FOV: 45 degrees:
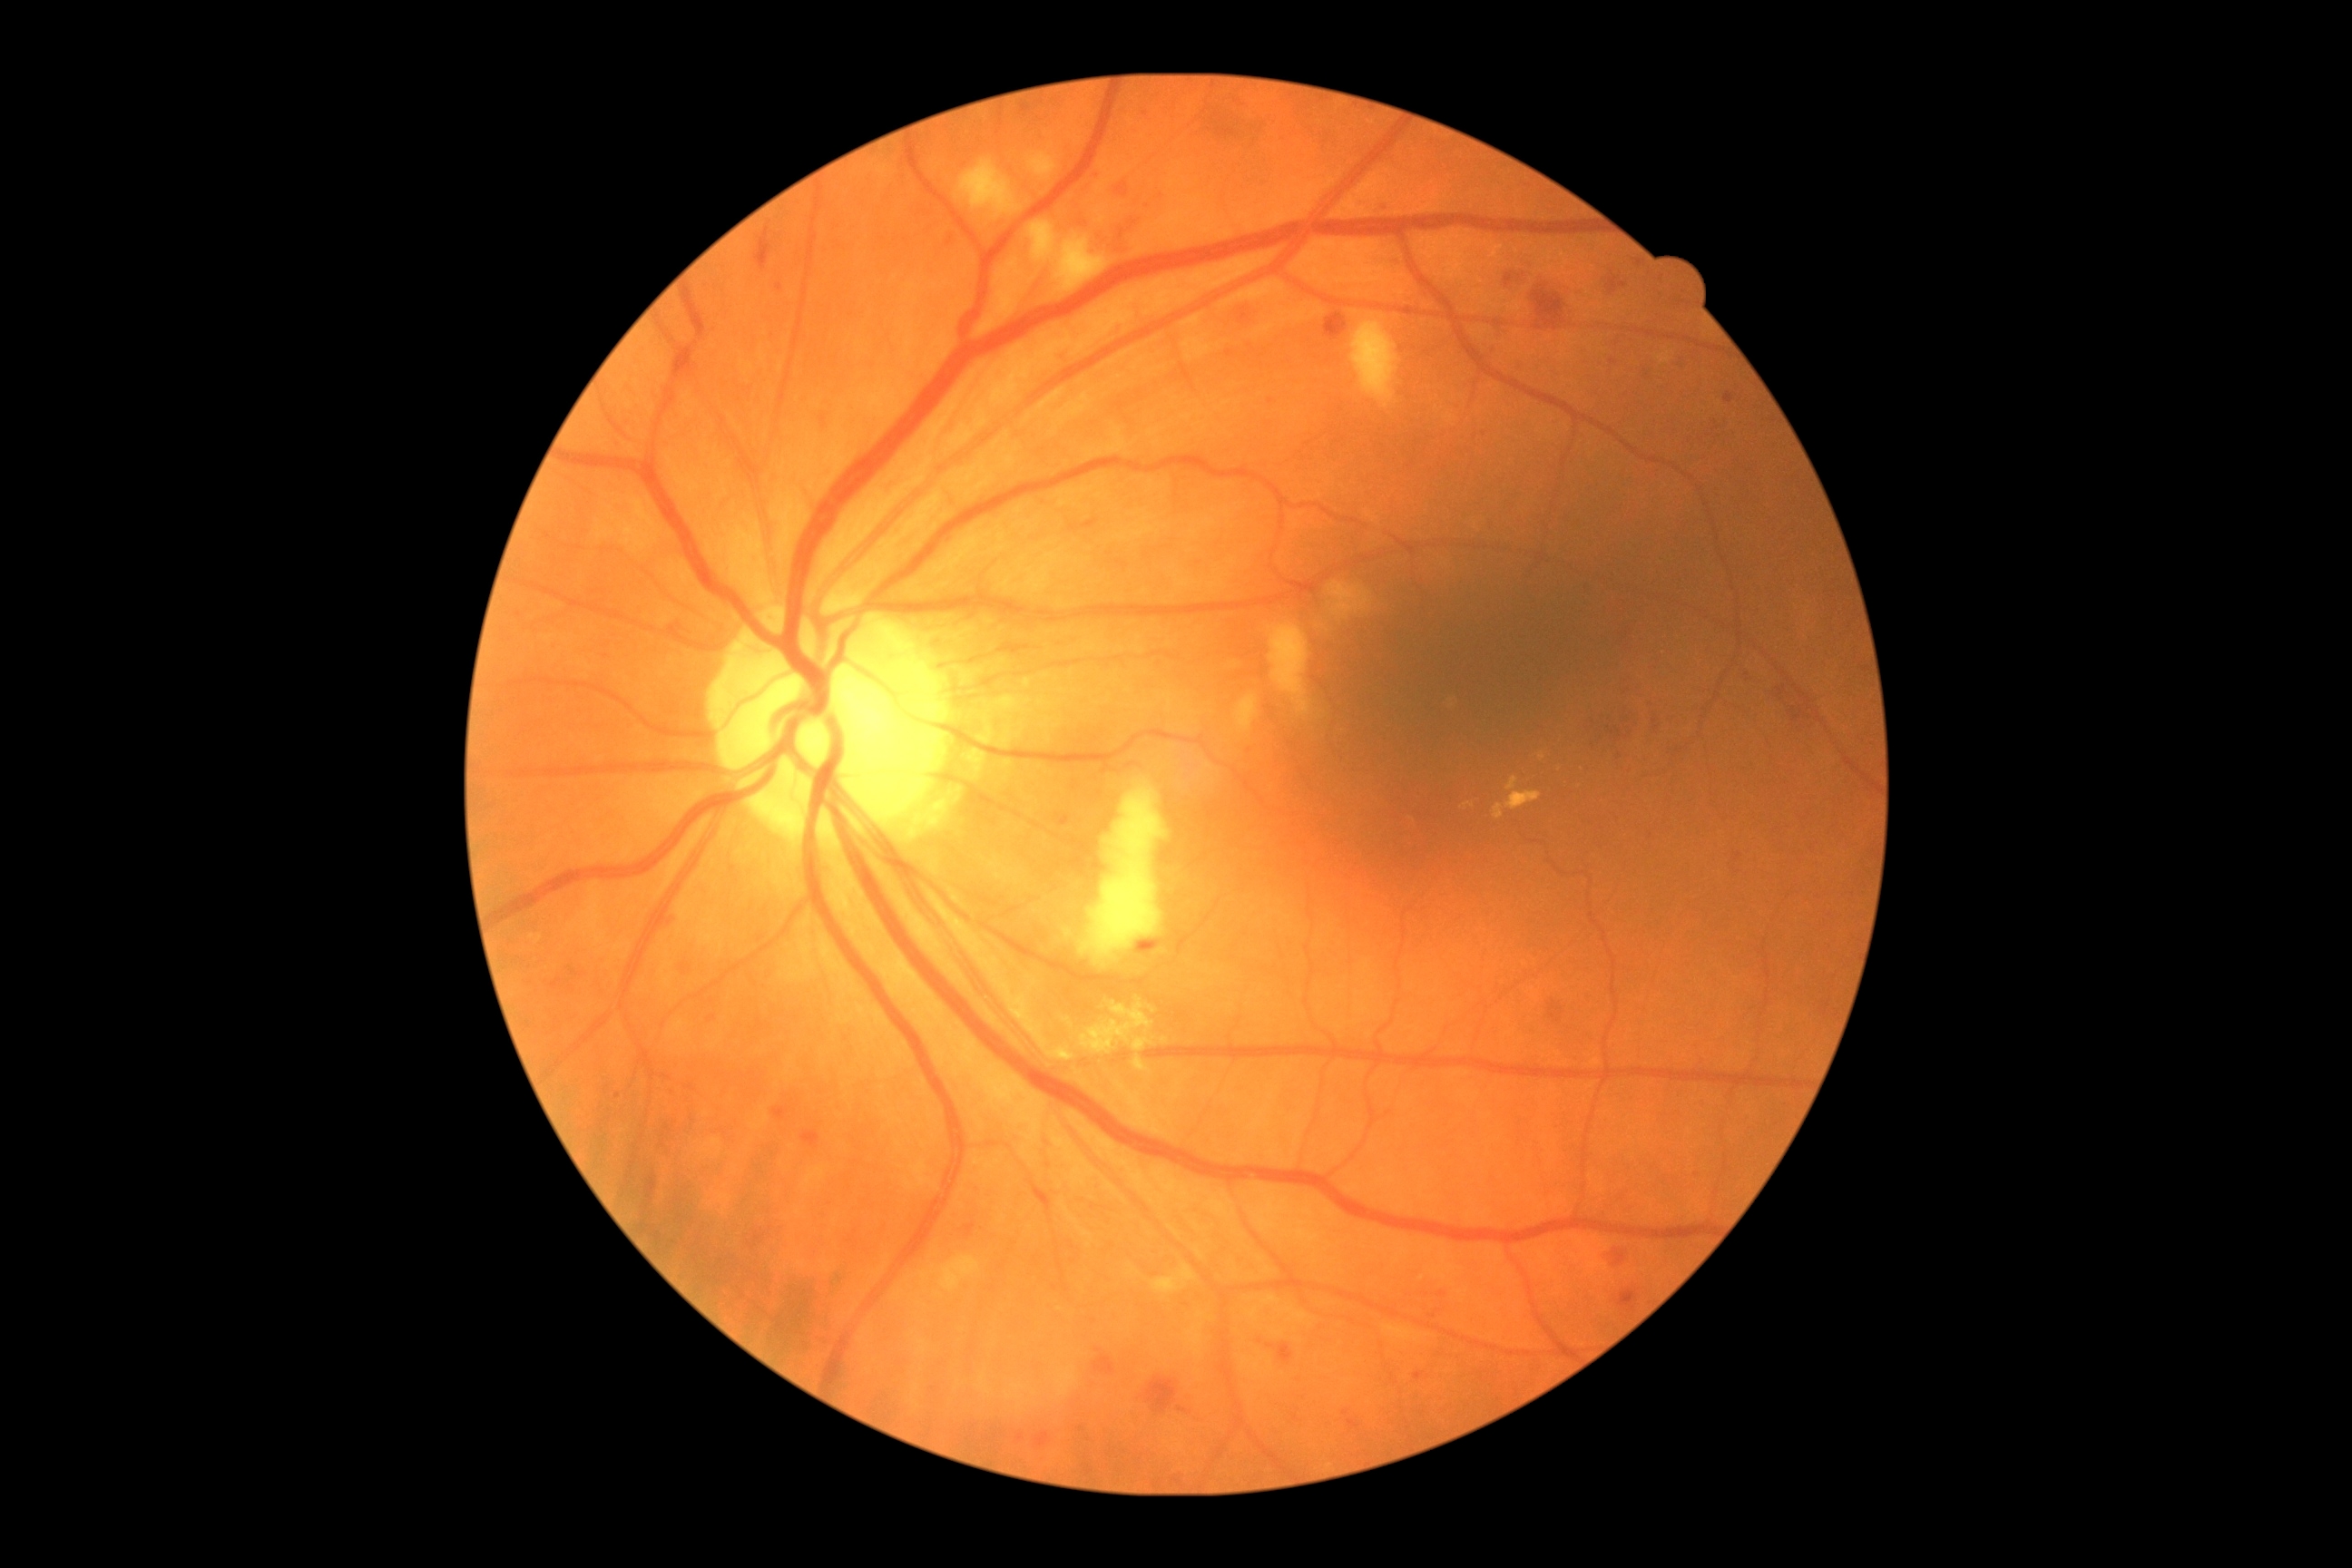 DR is grade 2 (moderate NPDR).